1932 by 1910 pixels:
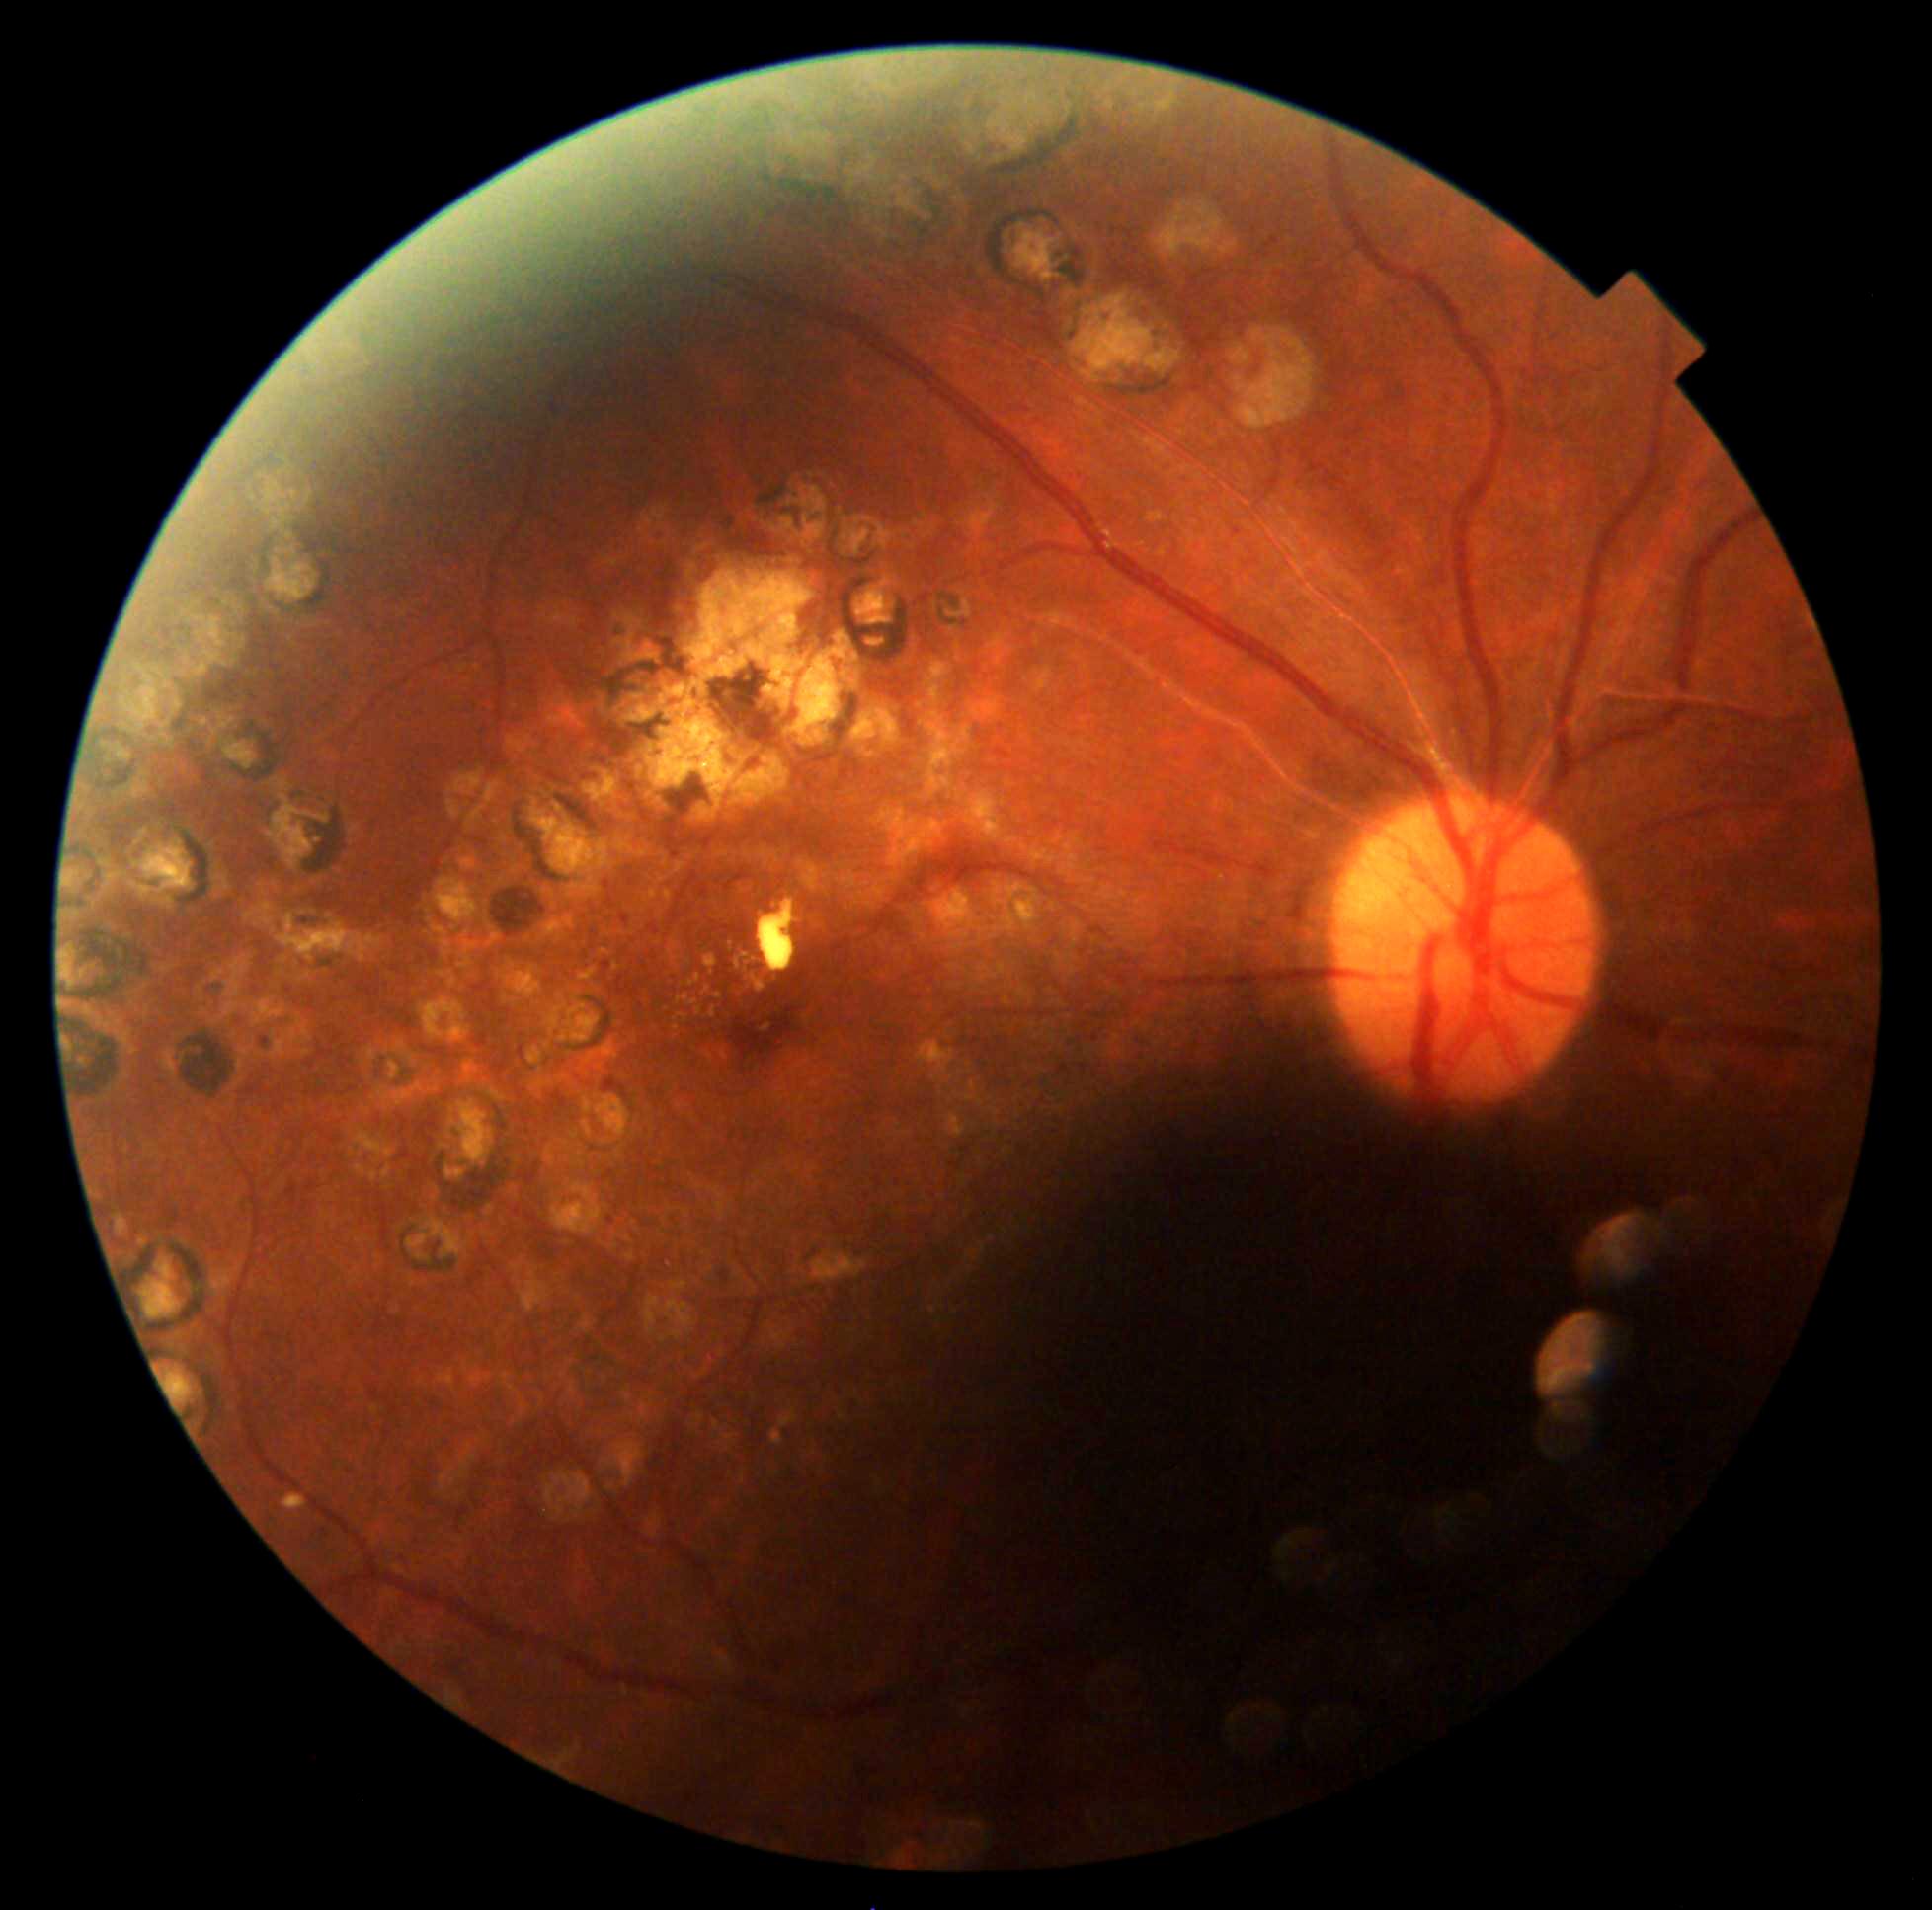
diabetic retinopathy (DR): 2/4; DR class: non-proliferative diabetic retinopathy.